CFP. 45° FOV
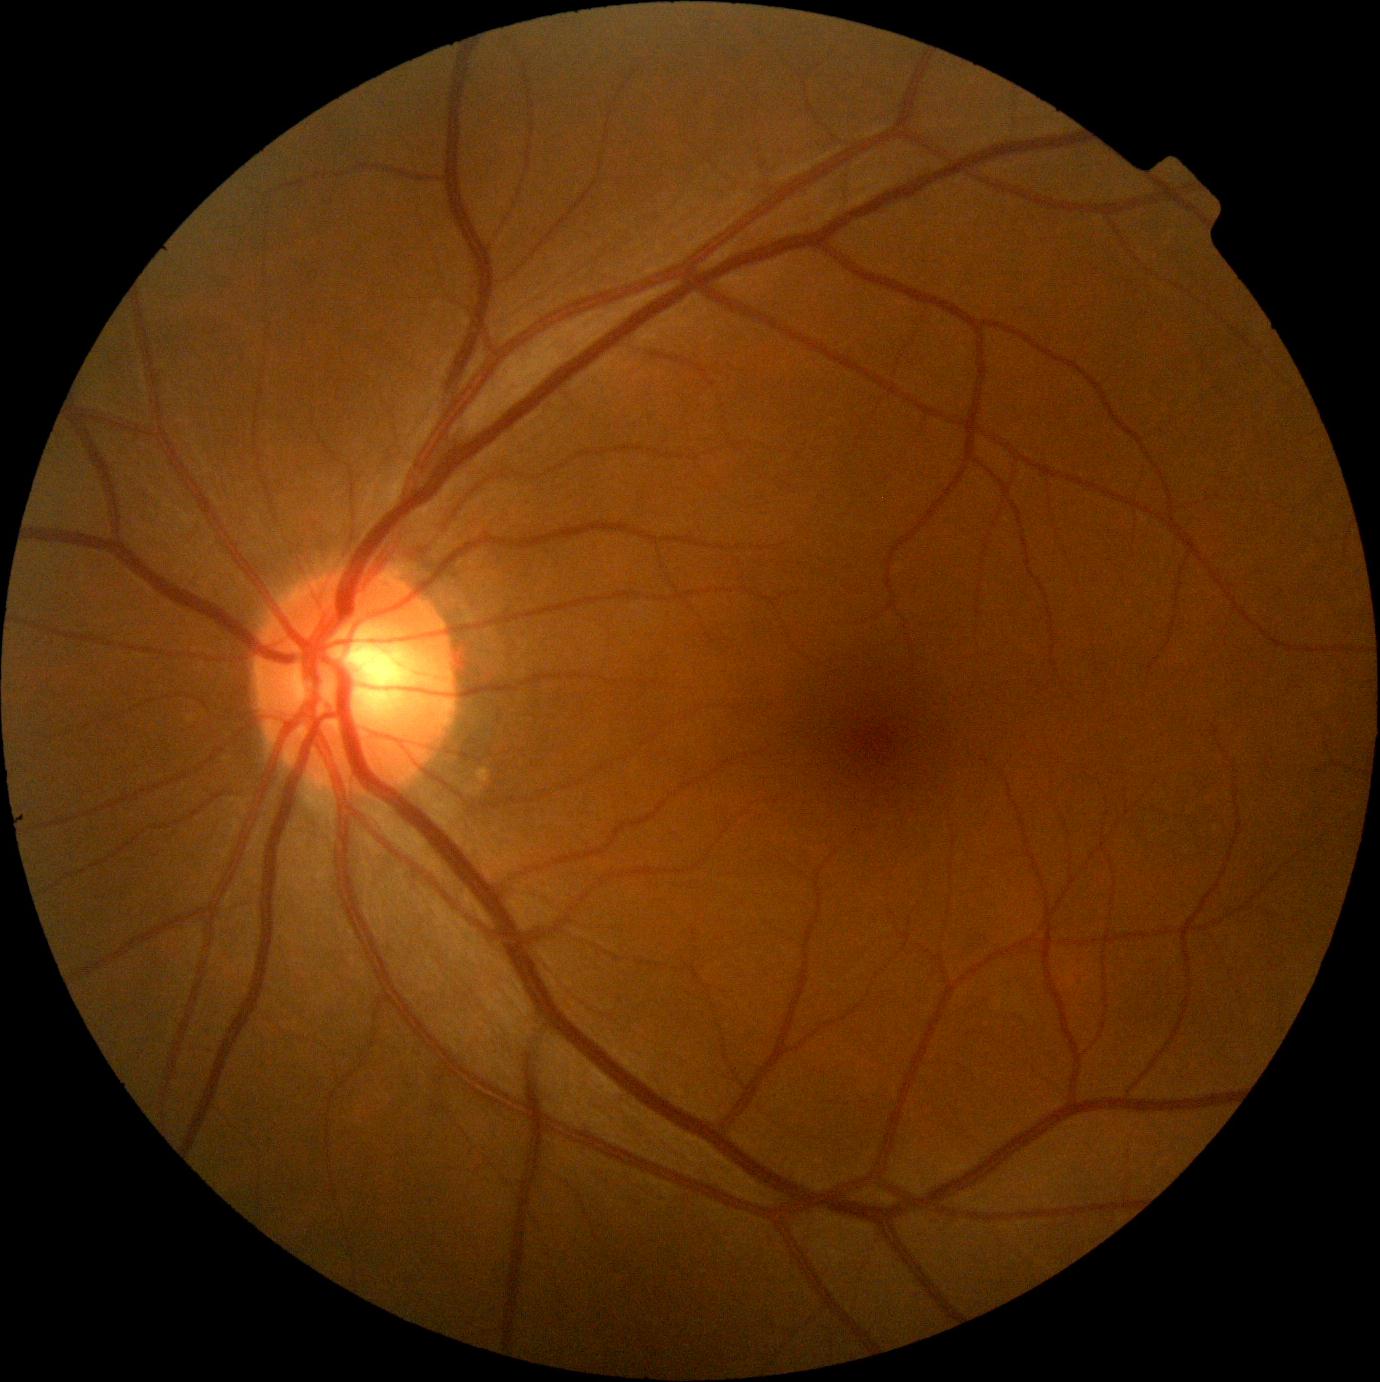 Retinopathy grade is 0/4.